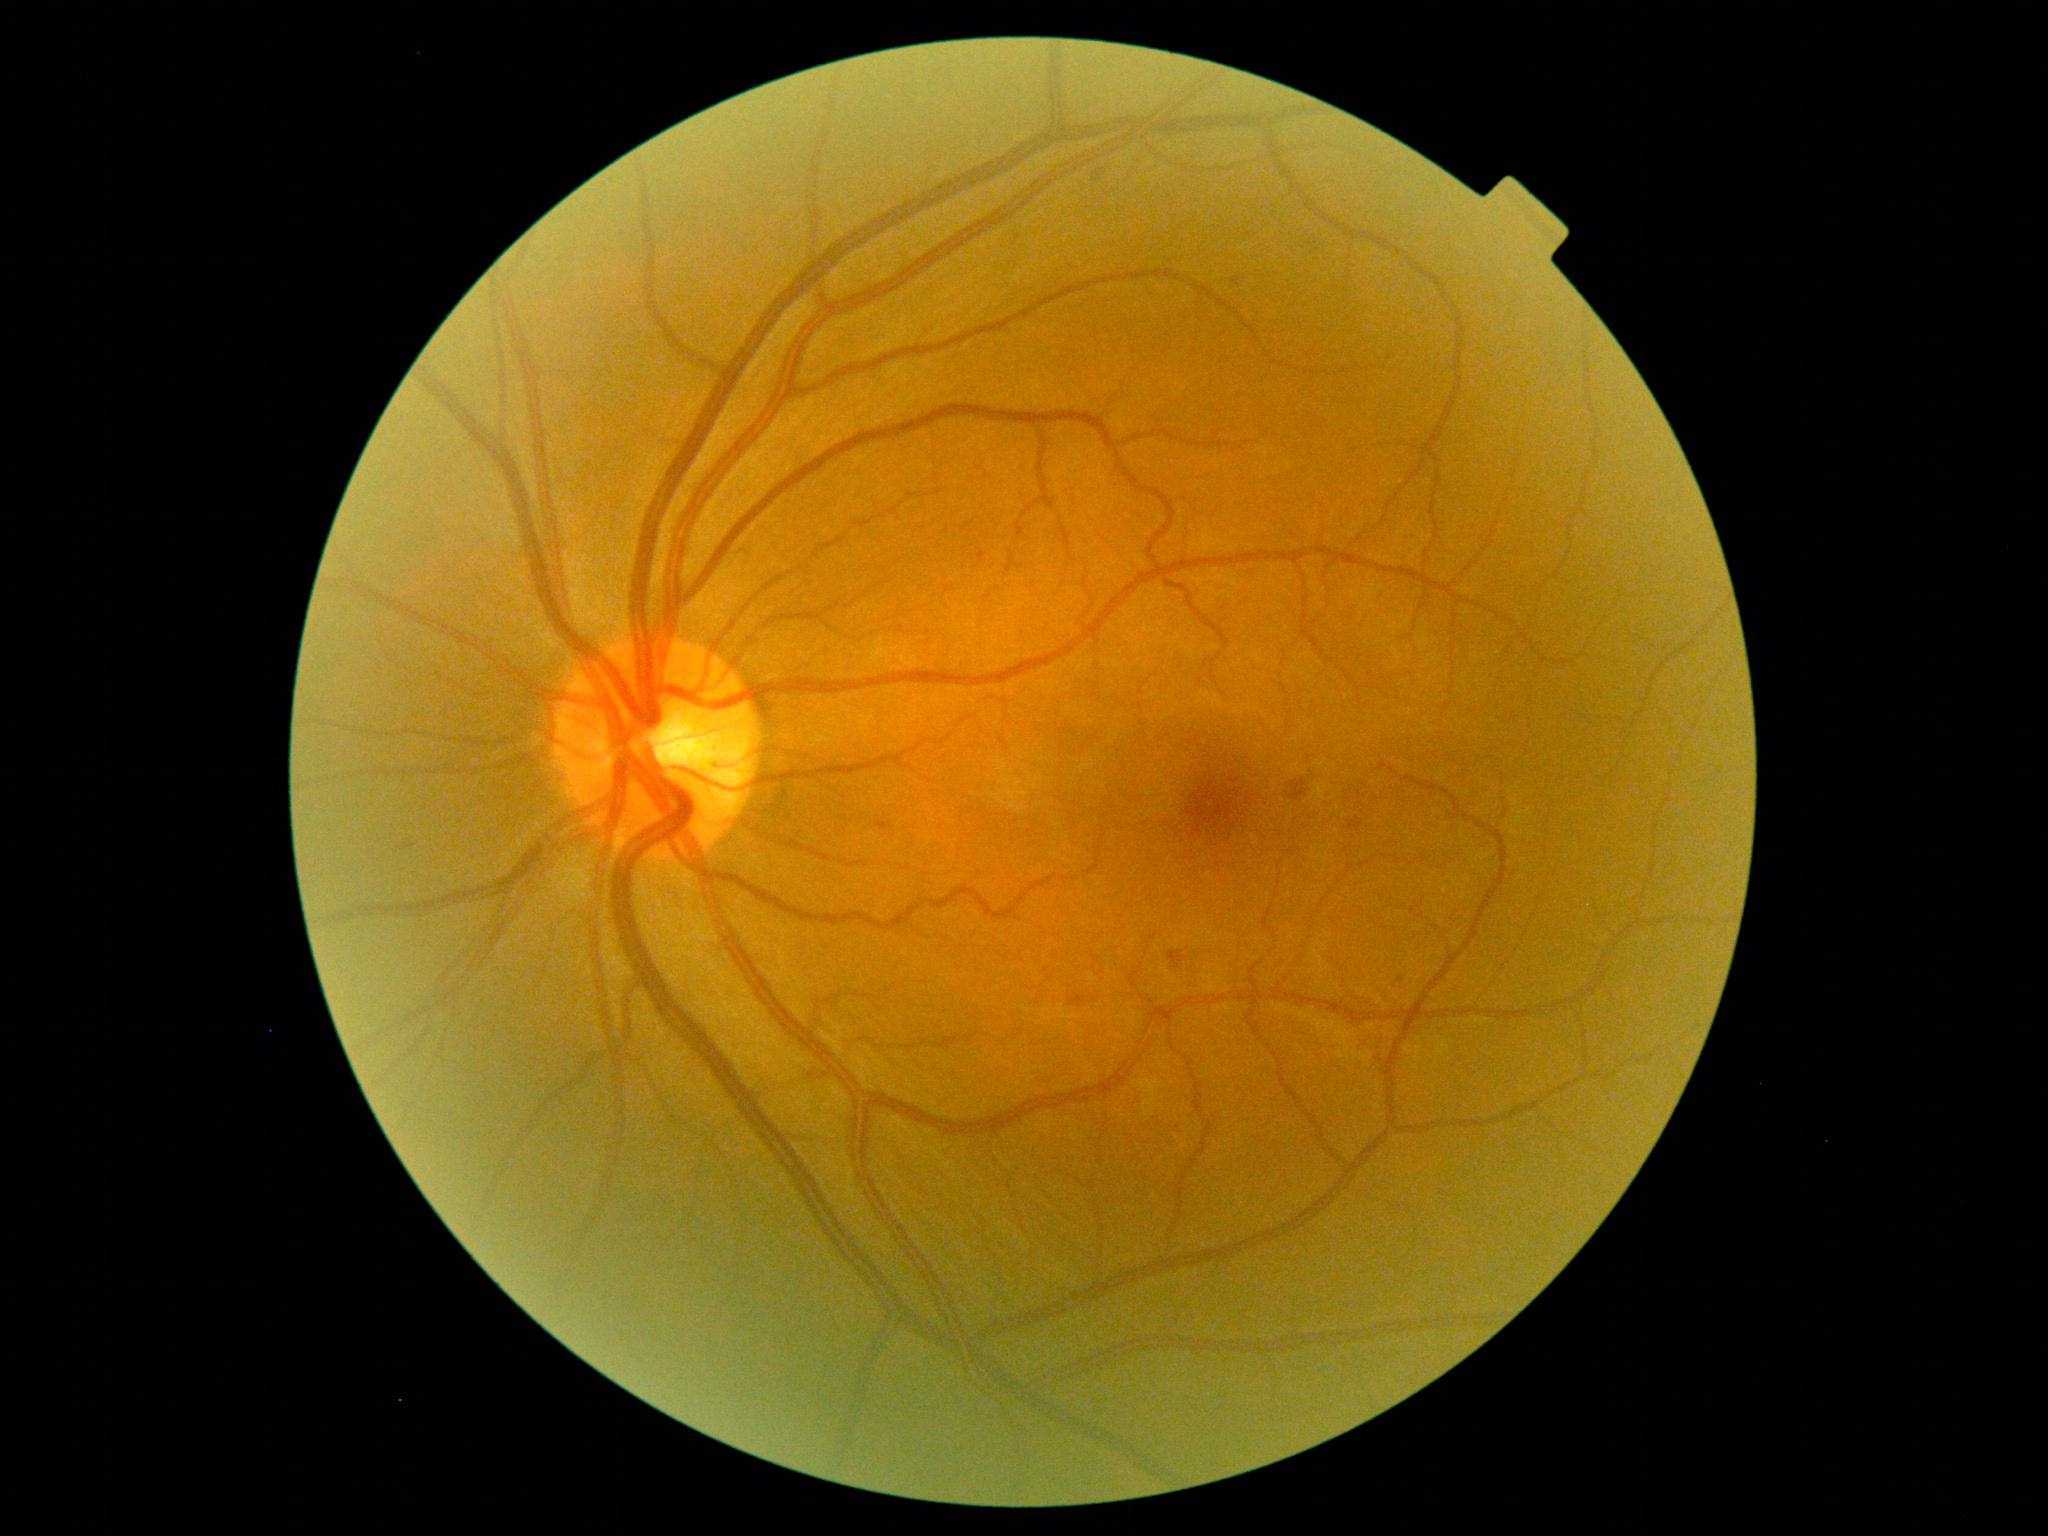 DR severity: grade 2 (moderate NPDR)
SEs: none
EXs: none
MAs: none
HEs: [1168, 950, 1188, 967] | [1069, 993, 1088, 1008] | [1289, 779, 1309, 802] | [875, 821, 895, 831]
Small HEs approximately at Point(1400, 979)